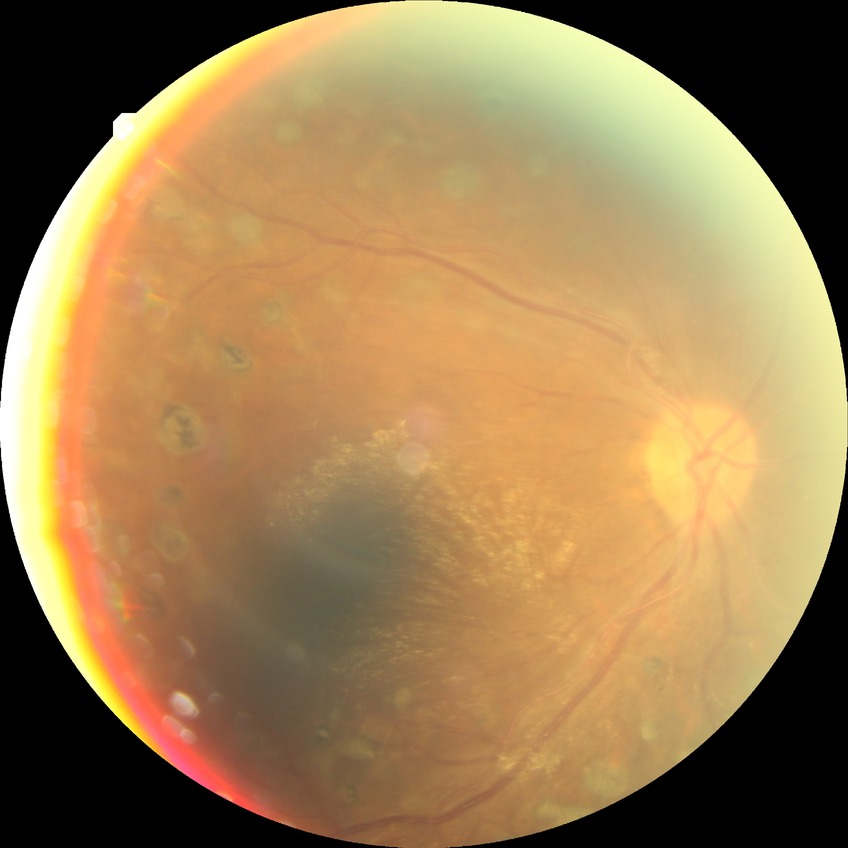
diabetic retinopathy (DR): PDR (proliferative diabetic retinopathy).